Color fundus image.
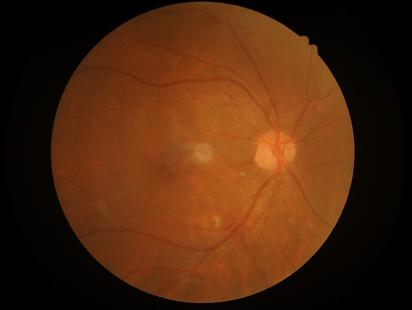
Quality assessment: overall: good and suitable for diagnostic use; clarity: clear with no noticeable blur; contrast: vessels and details readily distinguishable; illumination: no over- or under-exposure.